RetCam wide-field infant fundus image; 130° field of view (Natus RetCam Envision); 1440x1080
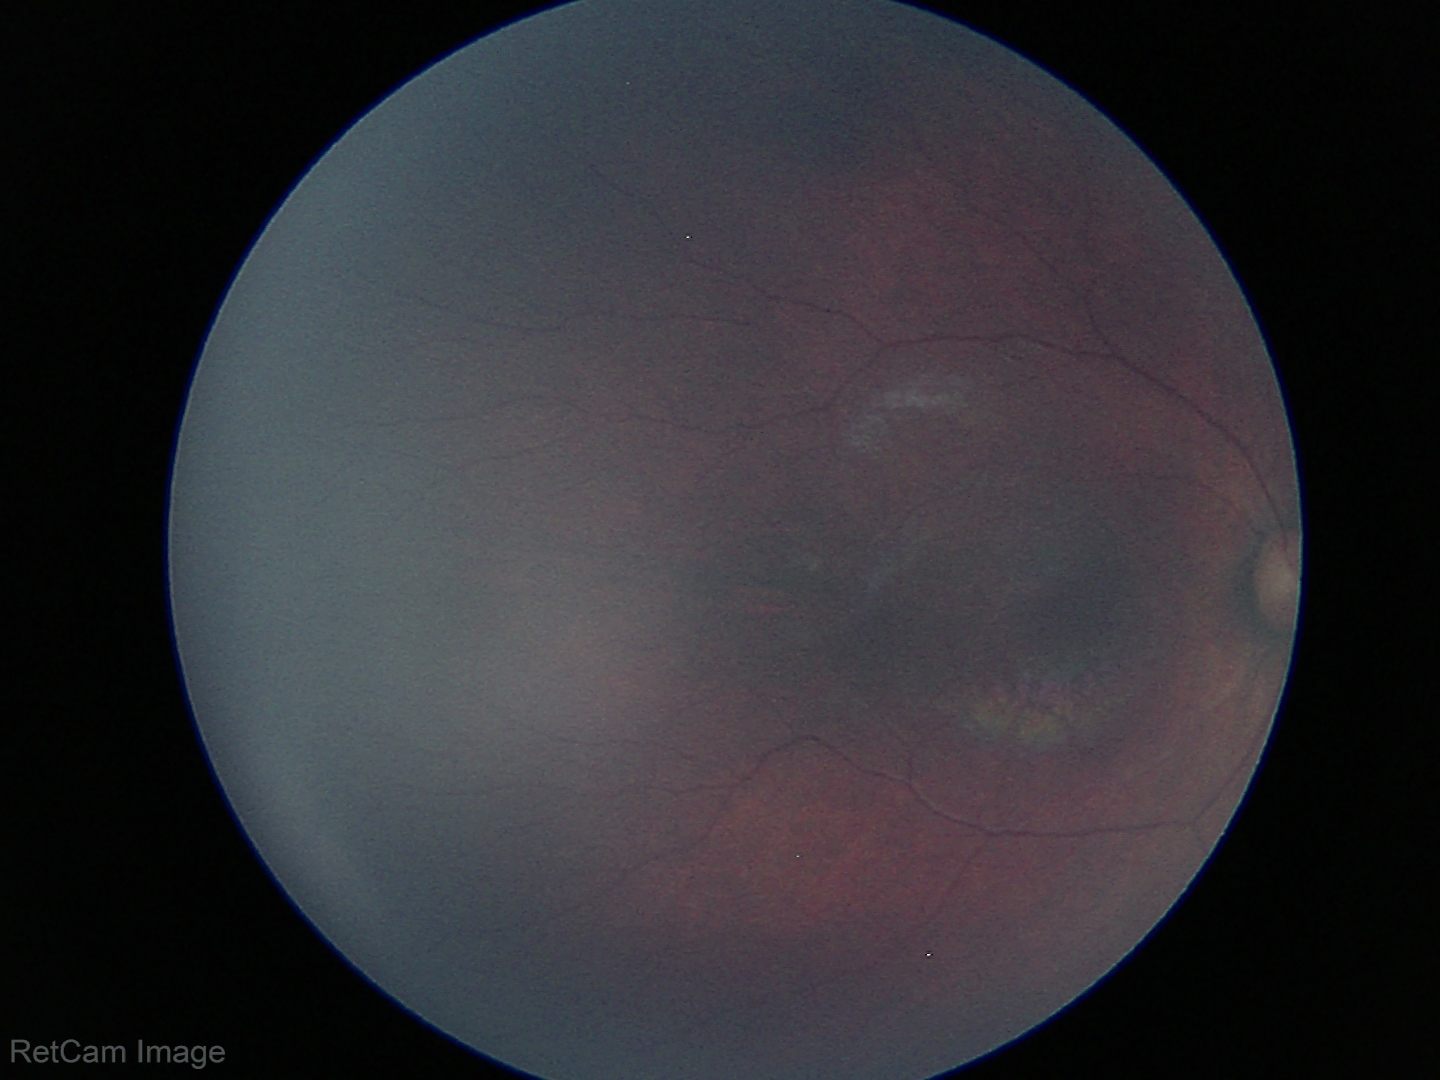
No retinal pathology identified on screening.